Wide-field fundus image from infant ROP screening · acquired on the Clarity RetCam 3 · 640x480px:
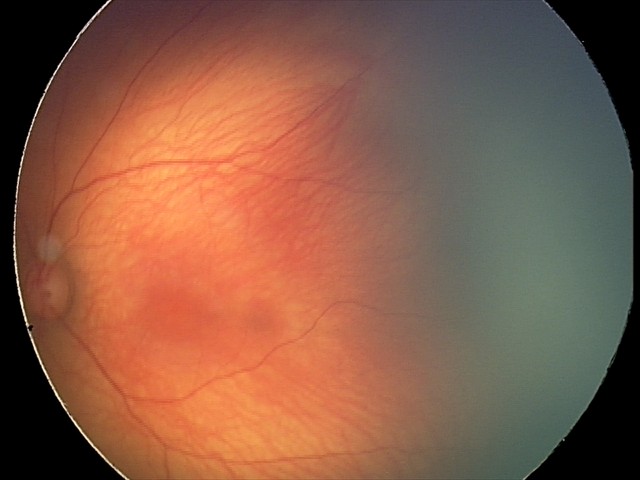 Q: What was the screening finding?
A: physiological appearance with no retinal pathology